Image size 2352x1568
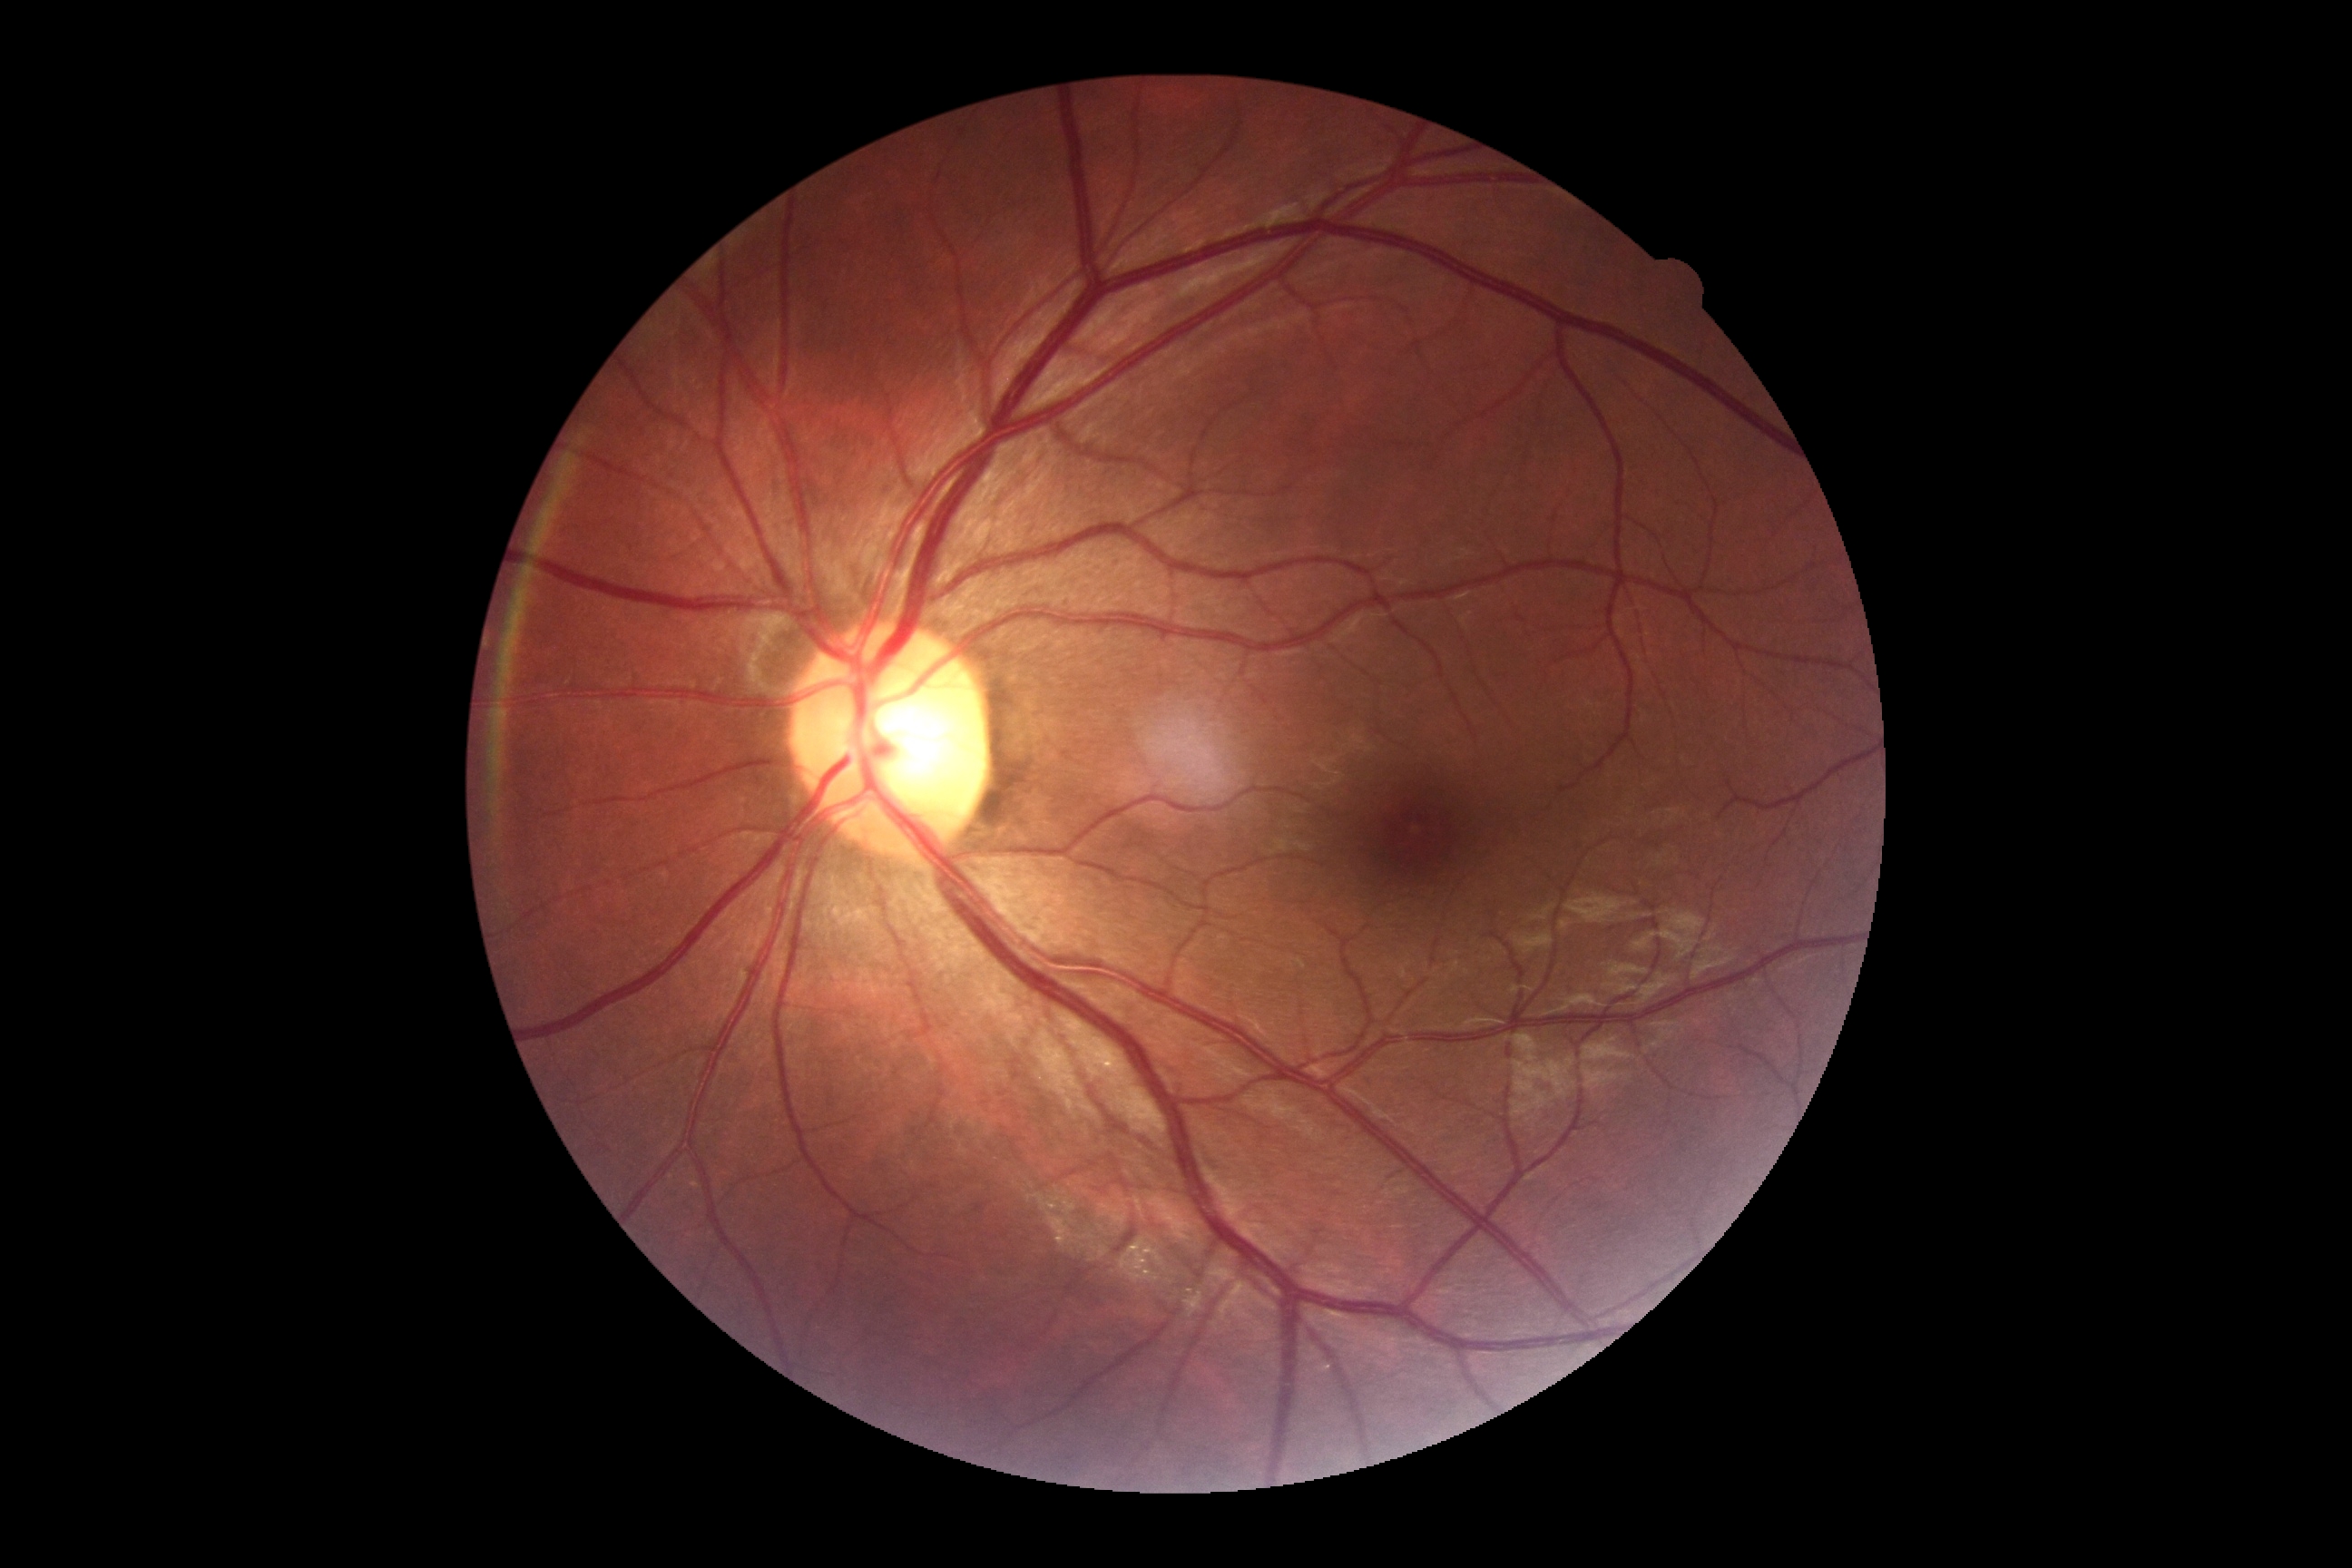

DR stage: grade 0.
No apparent diabetic retinopathy.